CFP, acquired with a NIDEK AFC-230.
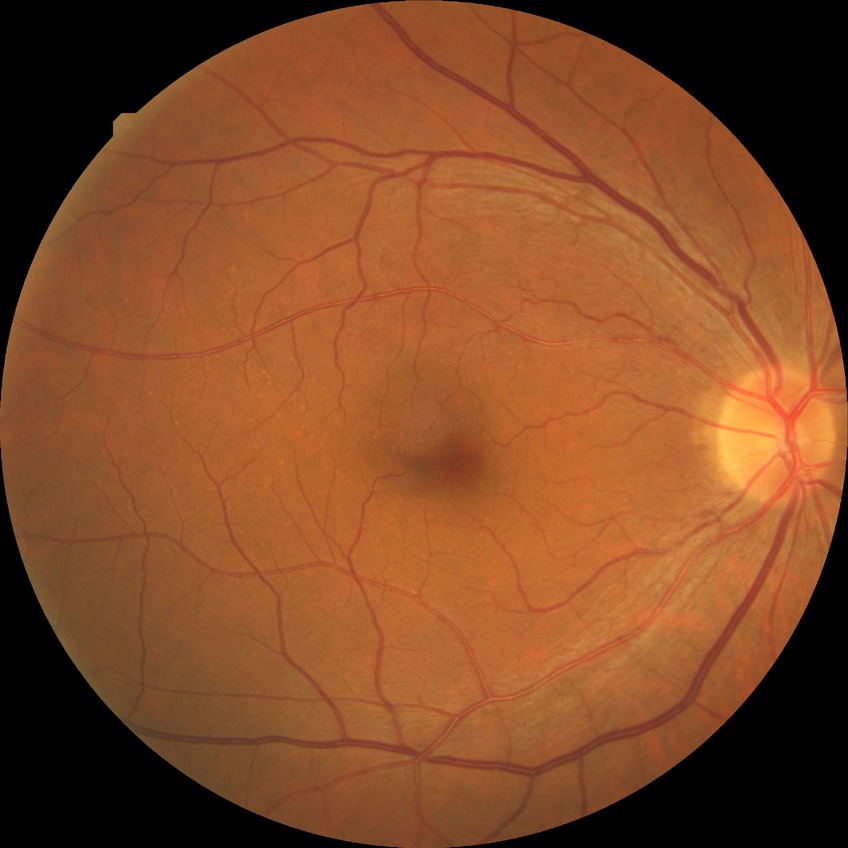
Retinopathy stage: no diabetic retinopathy.